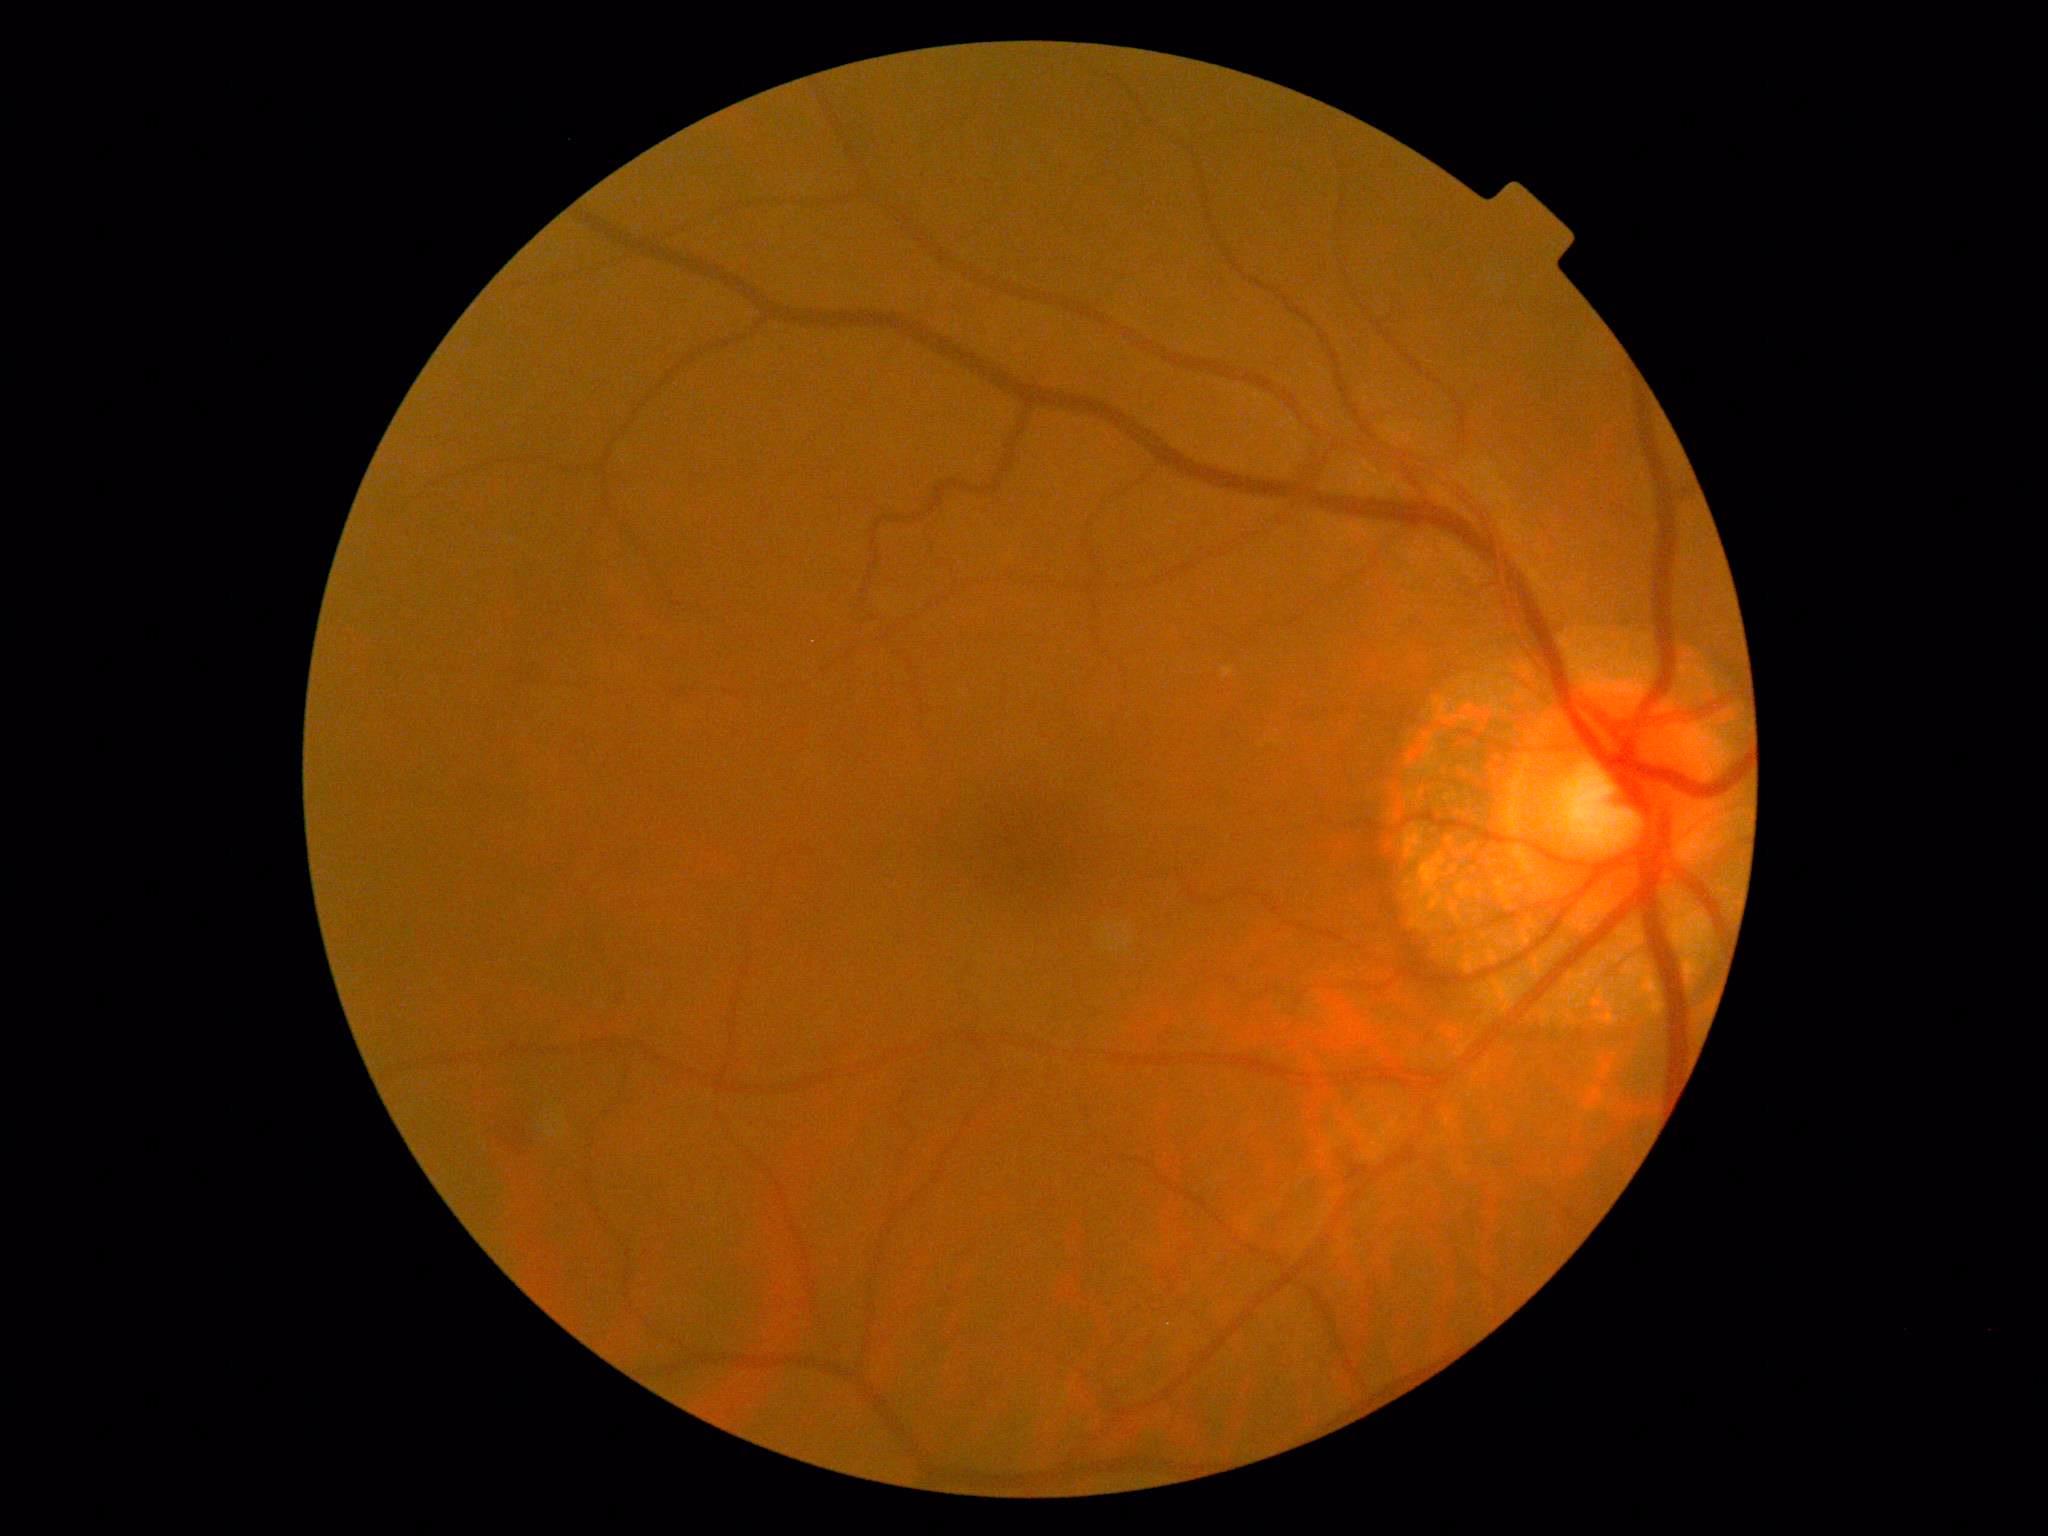

  dr_grade: 2 — more than just microaneurysms but less than severe NPDR